Modified Davis grading:
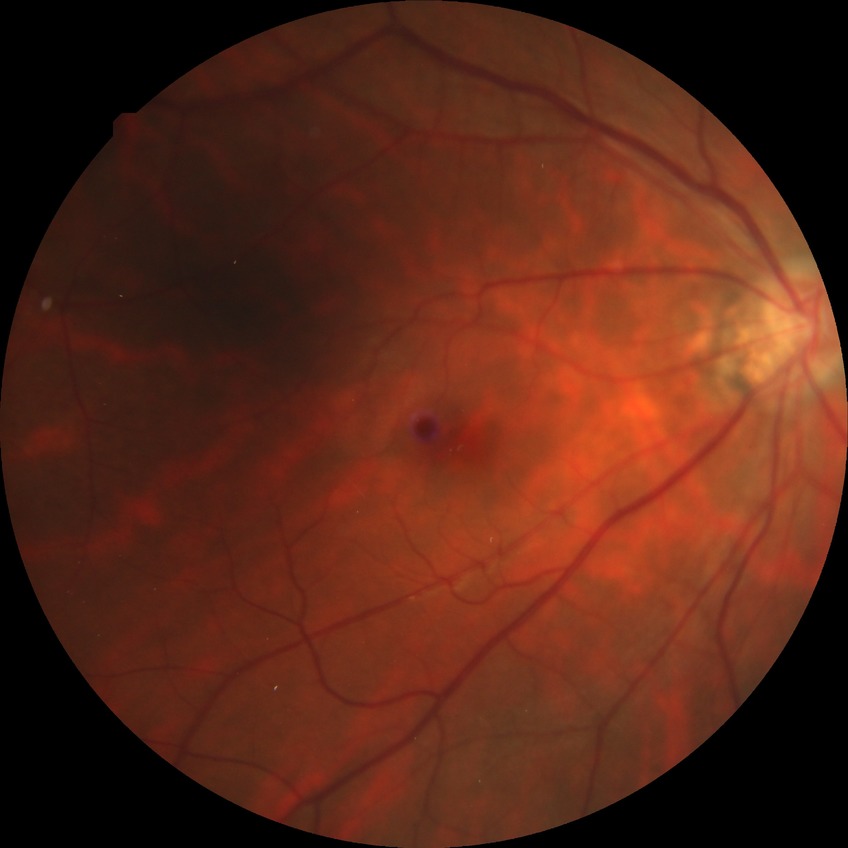

DR is NDR.